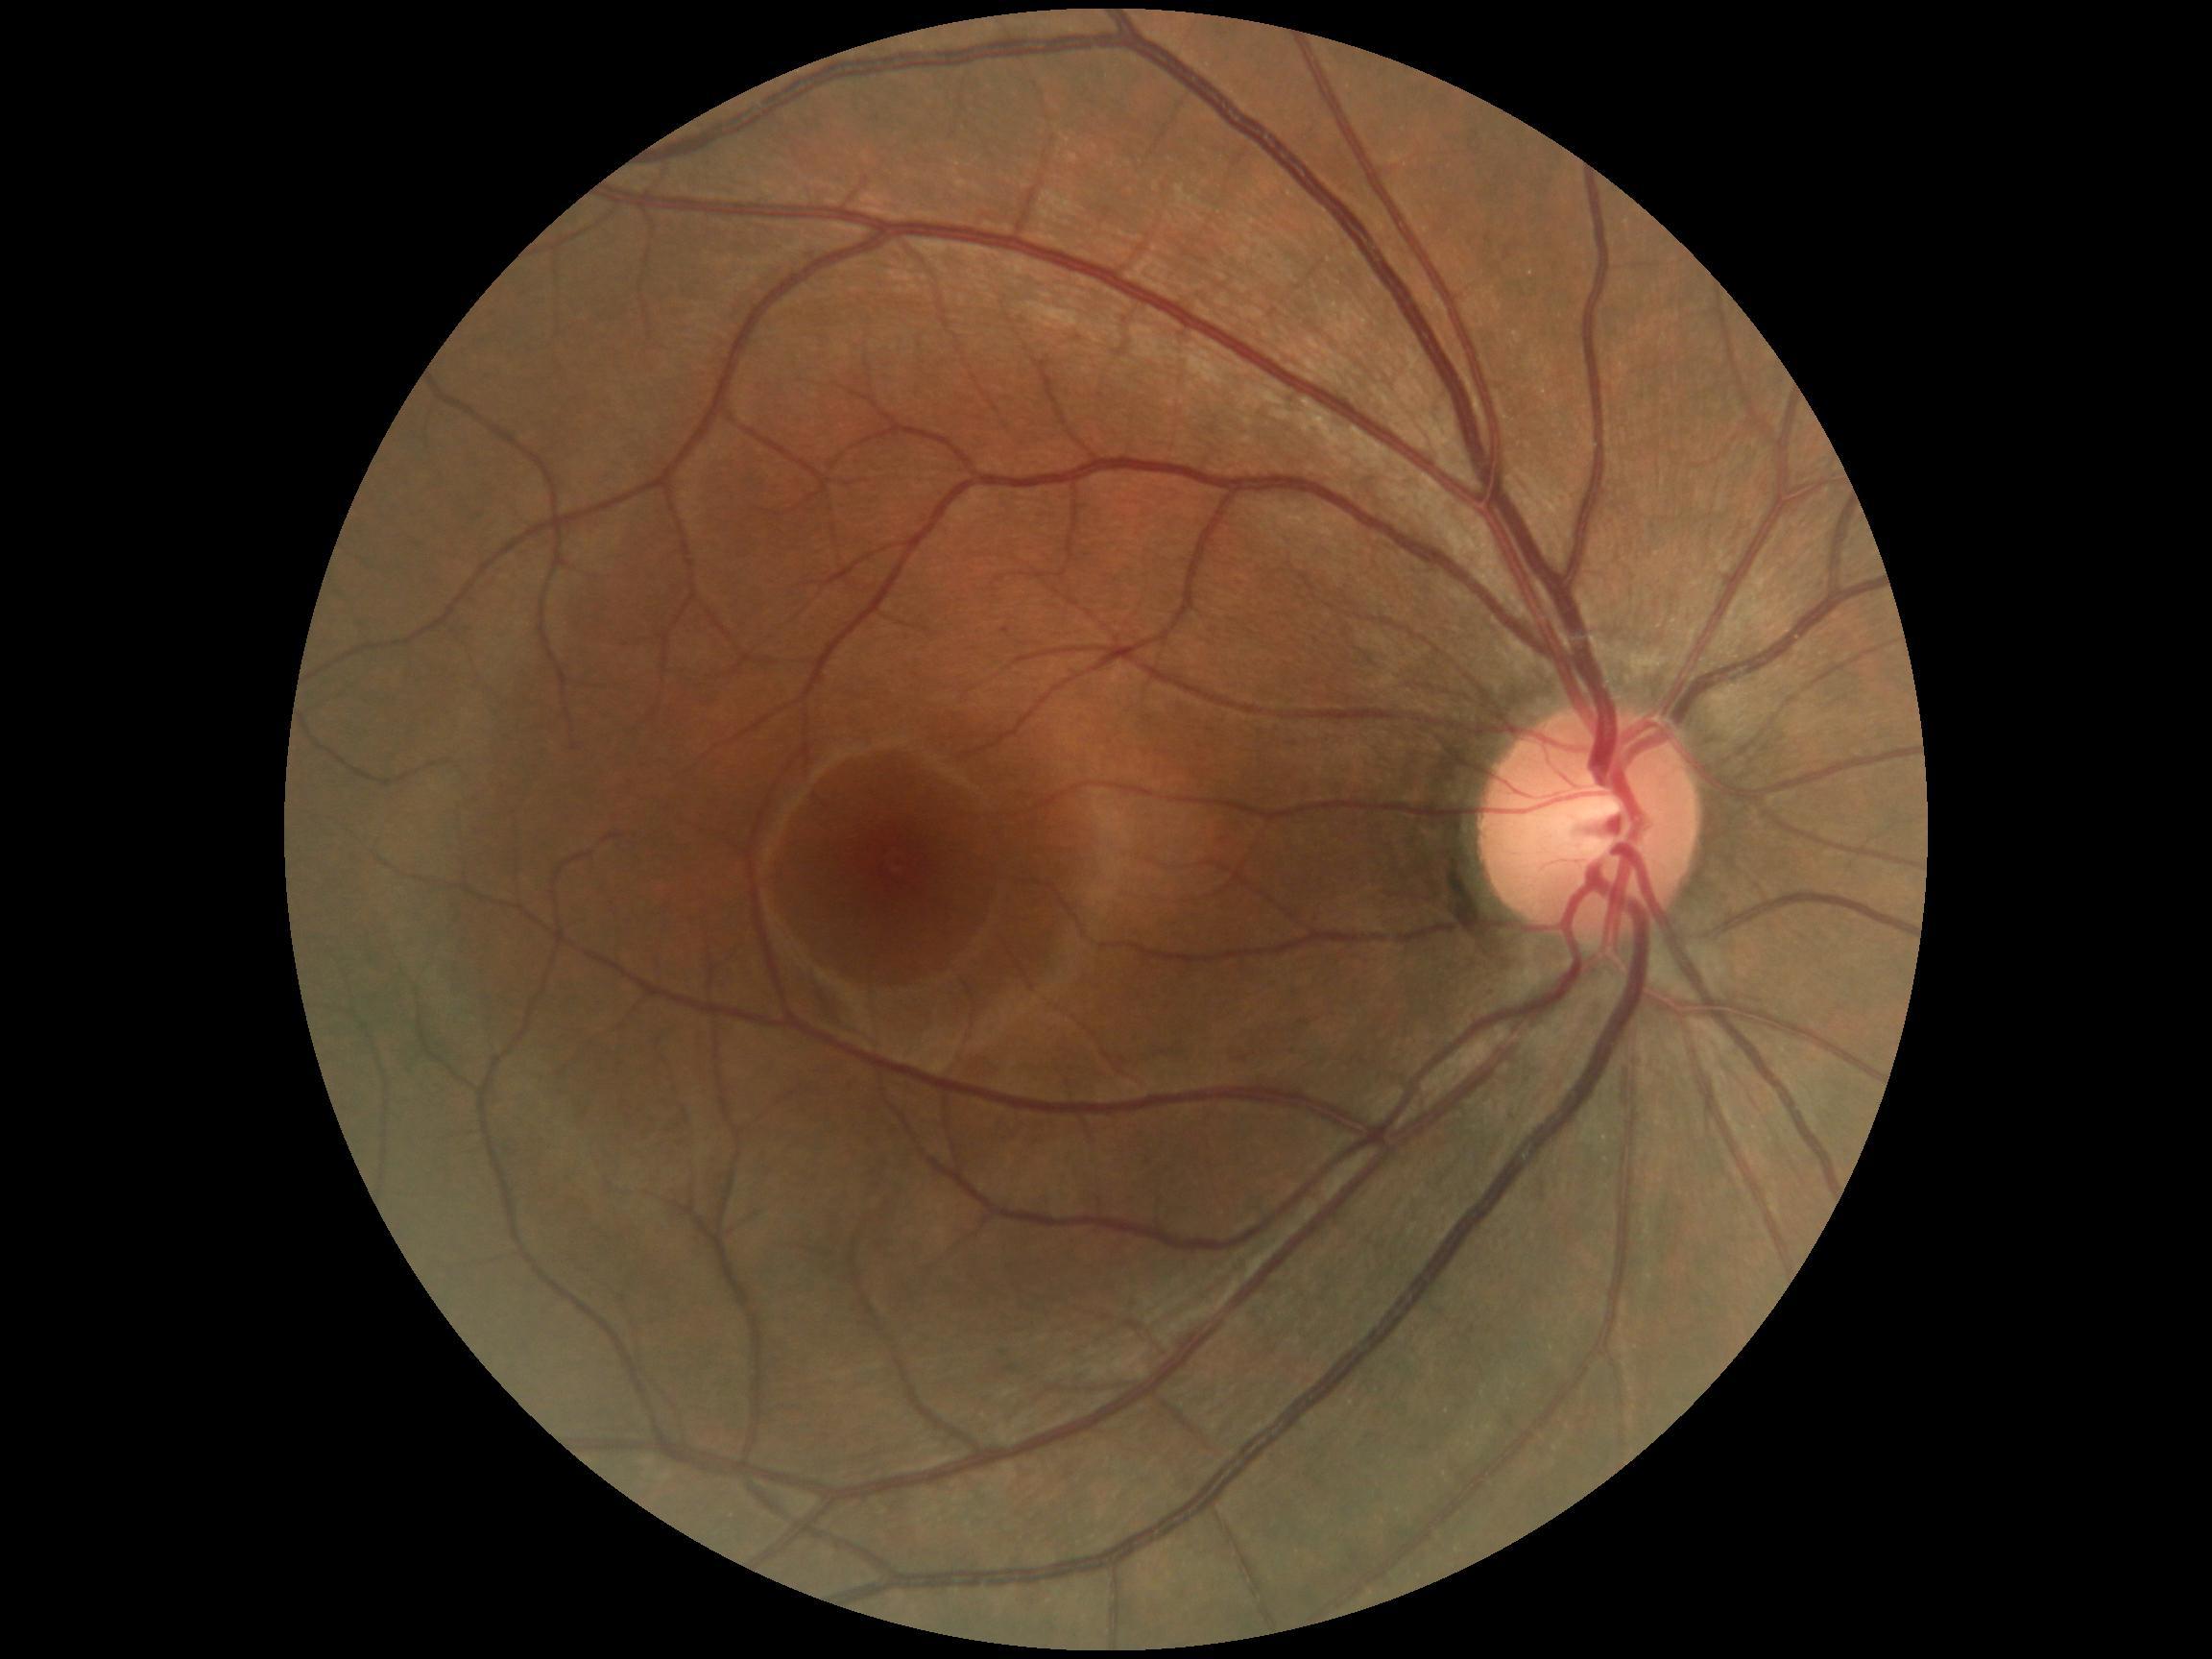 diabetic retinopathy severity: no apparent diabetic retinopathy (grade 0), DR impression: negative for DR.